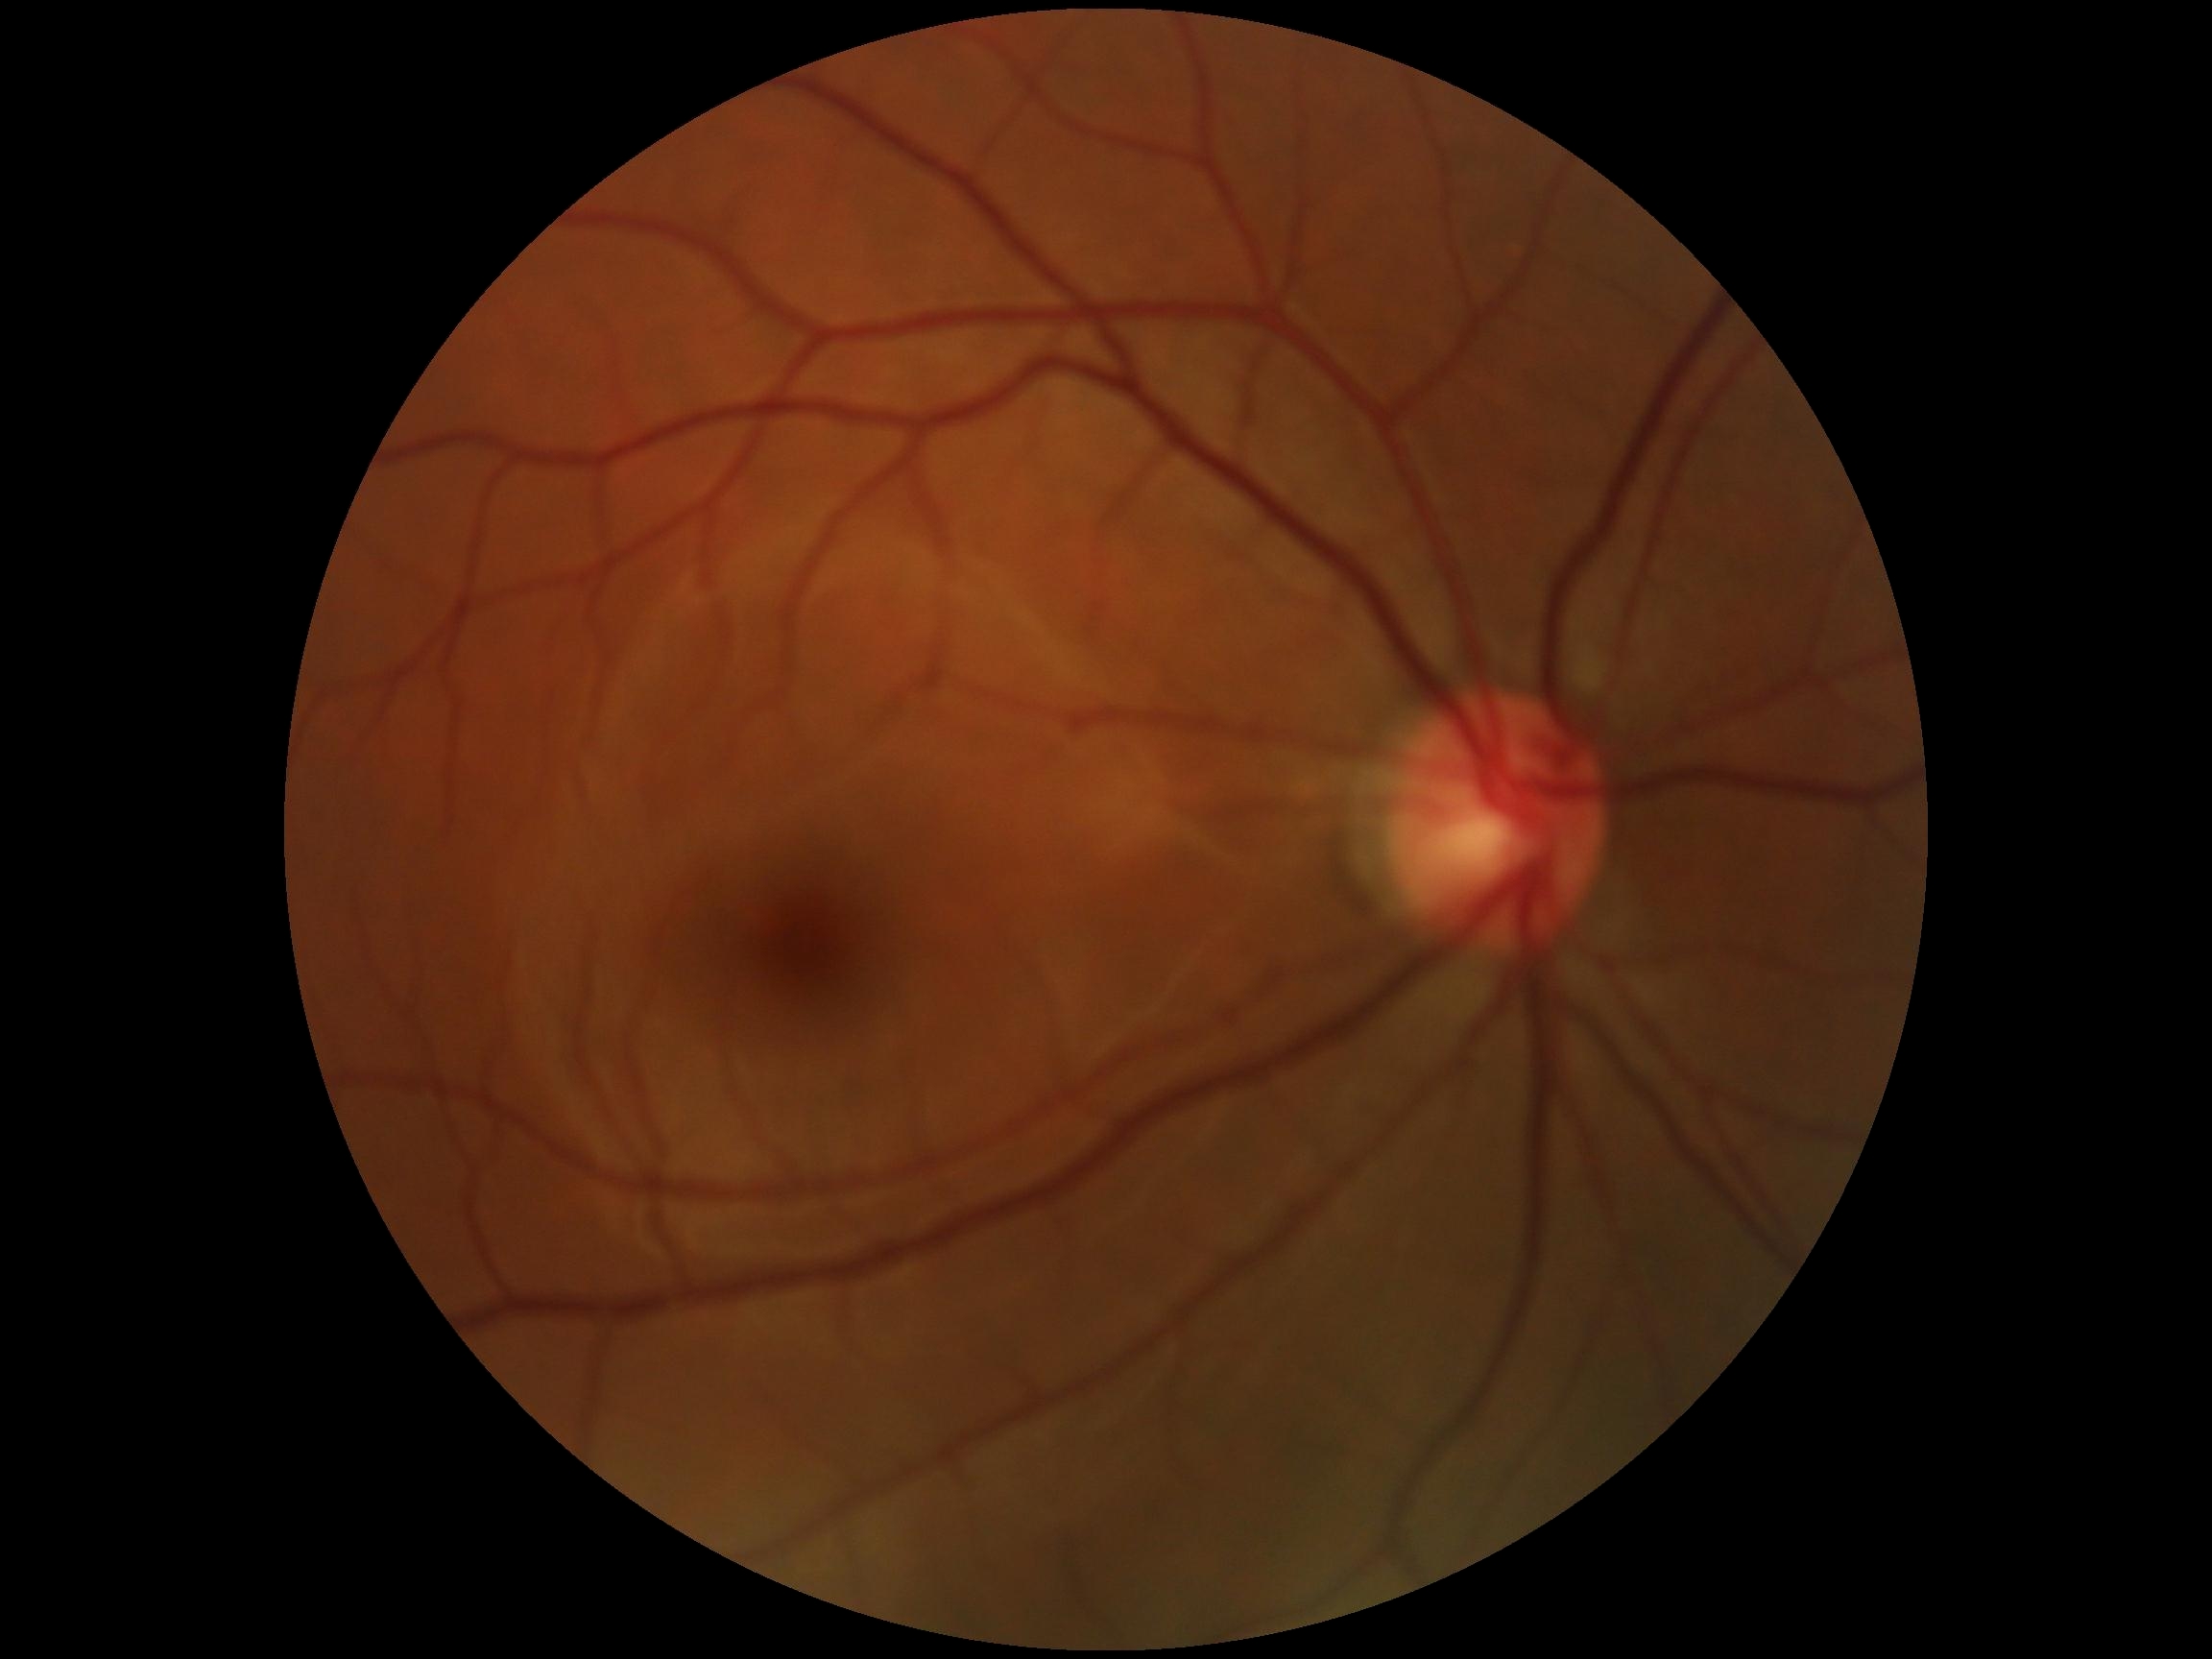
diabetic retinopathy grade: no apparent diabetic retinopathy (0)